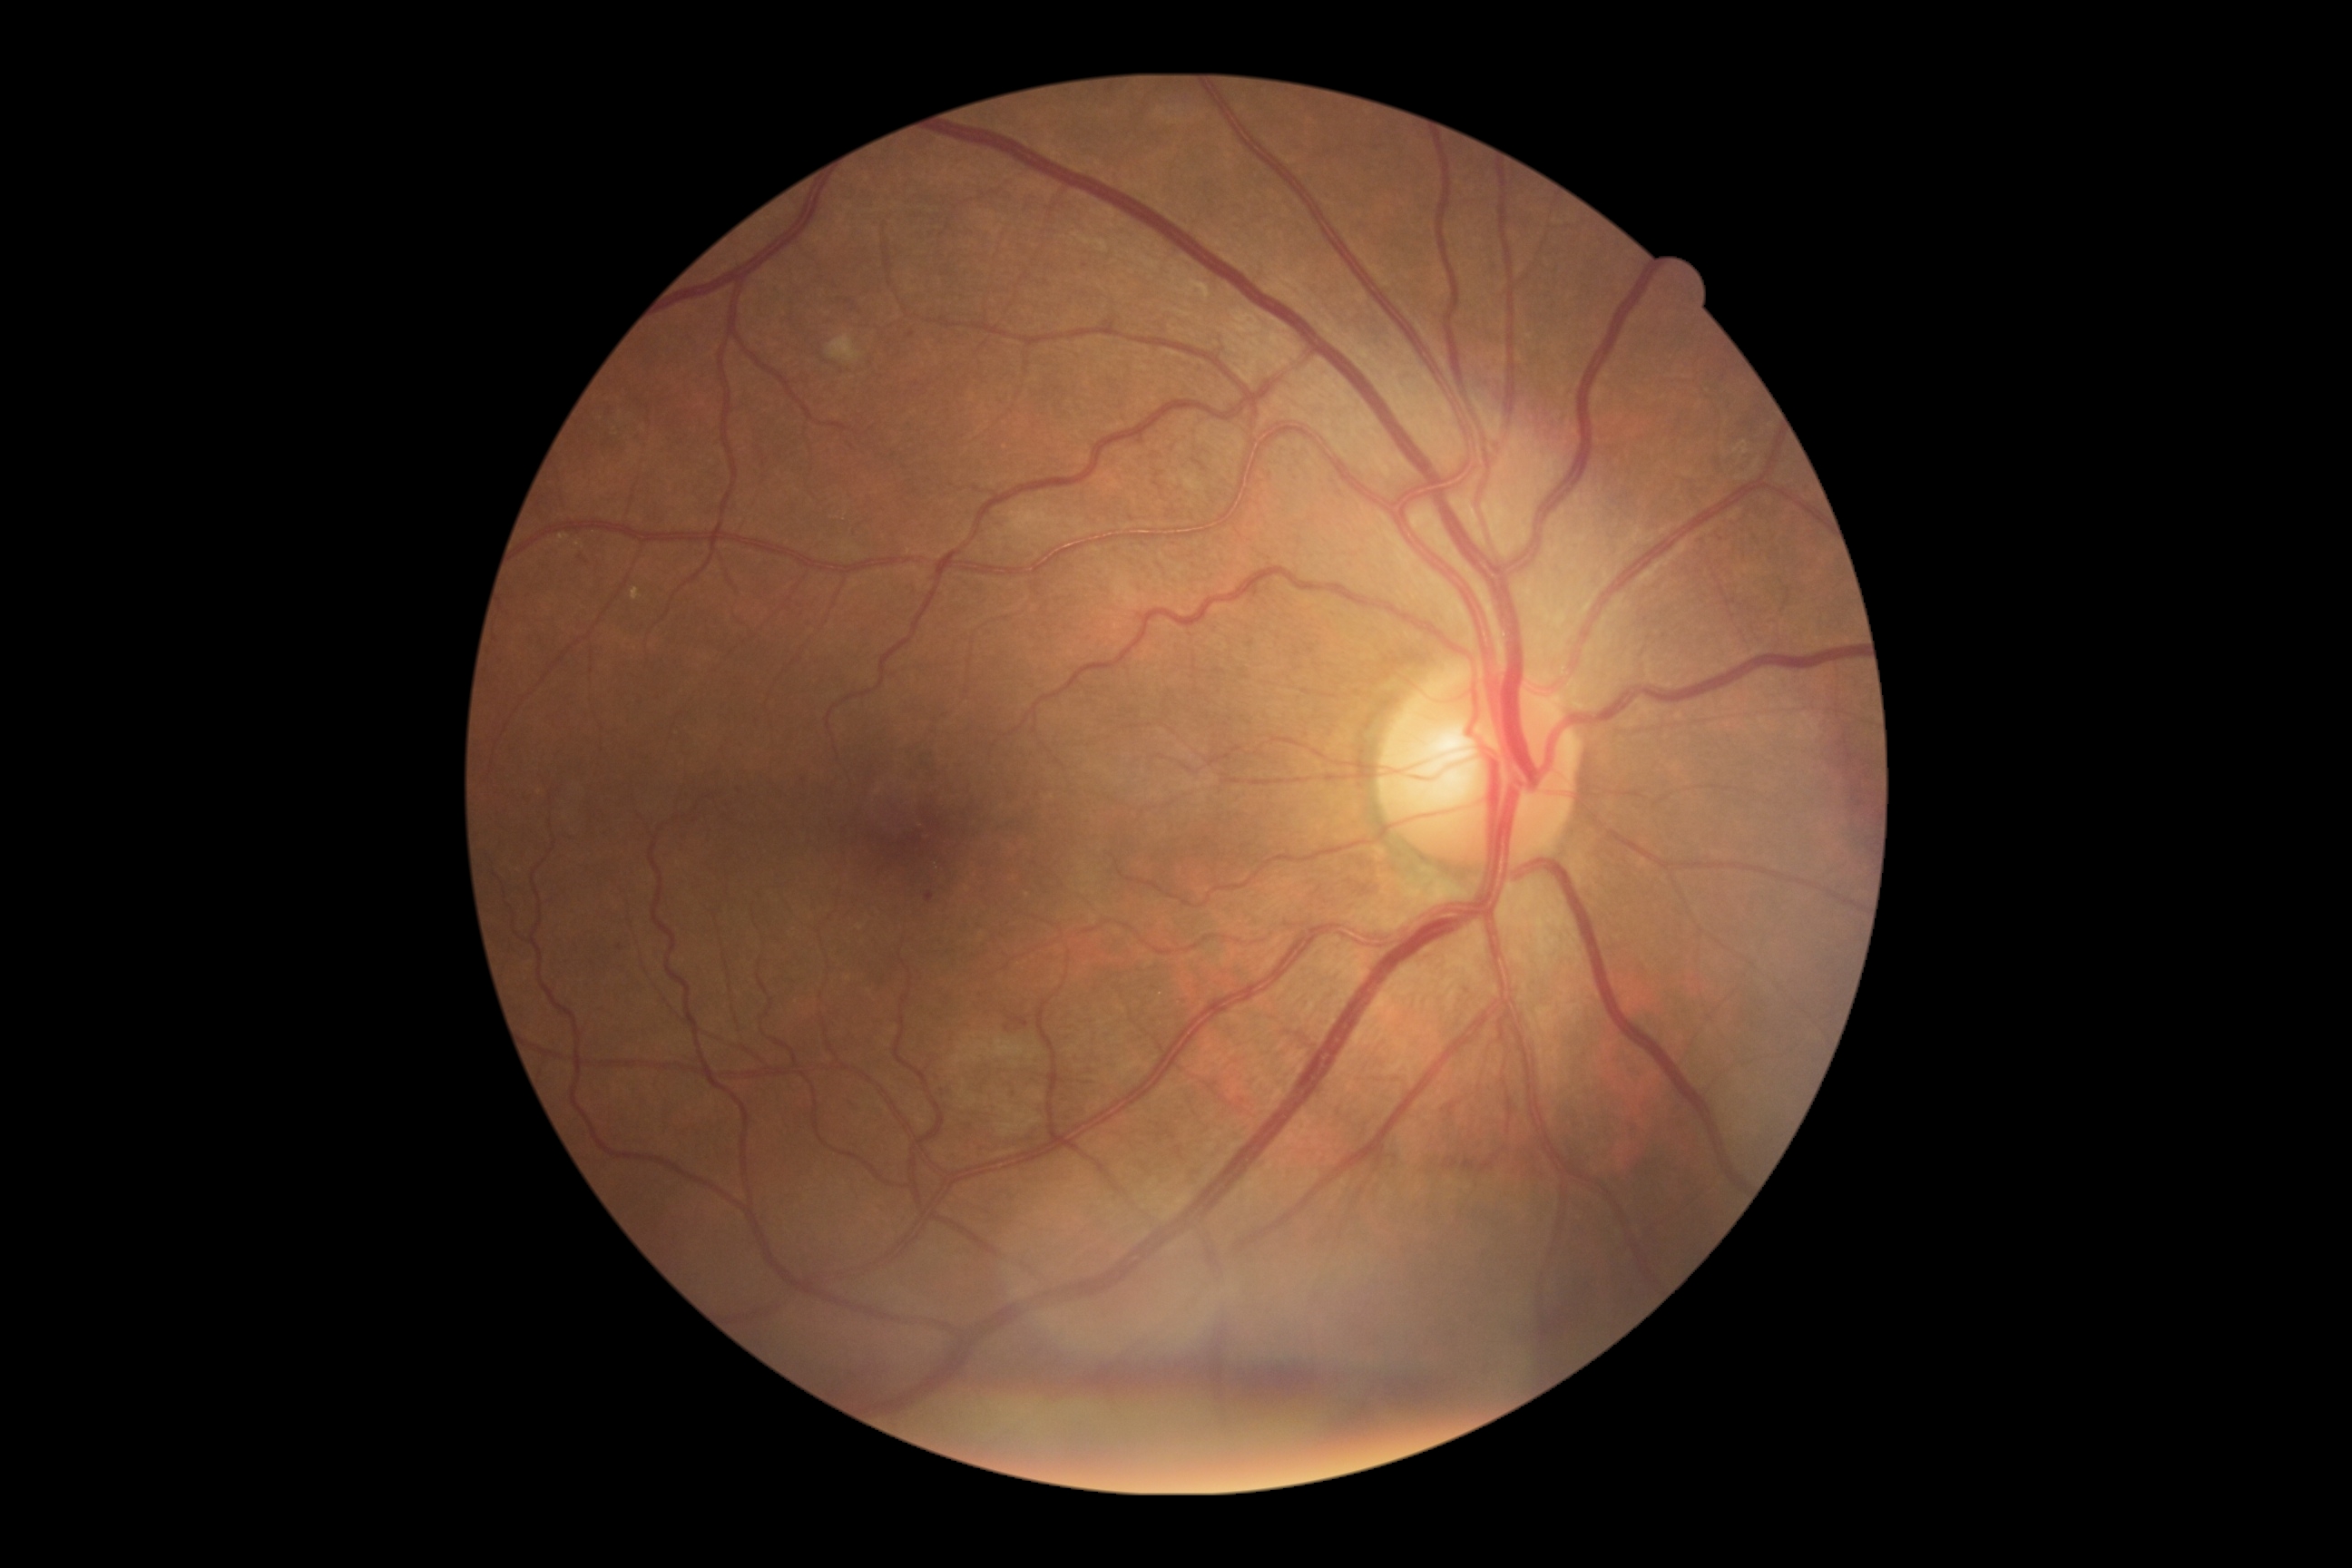 {"dr_grade": "2"}